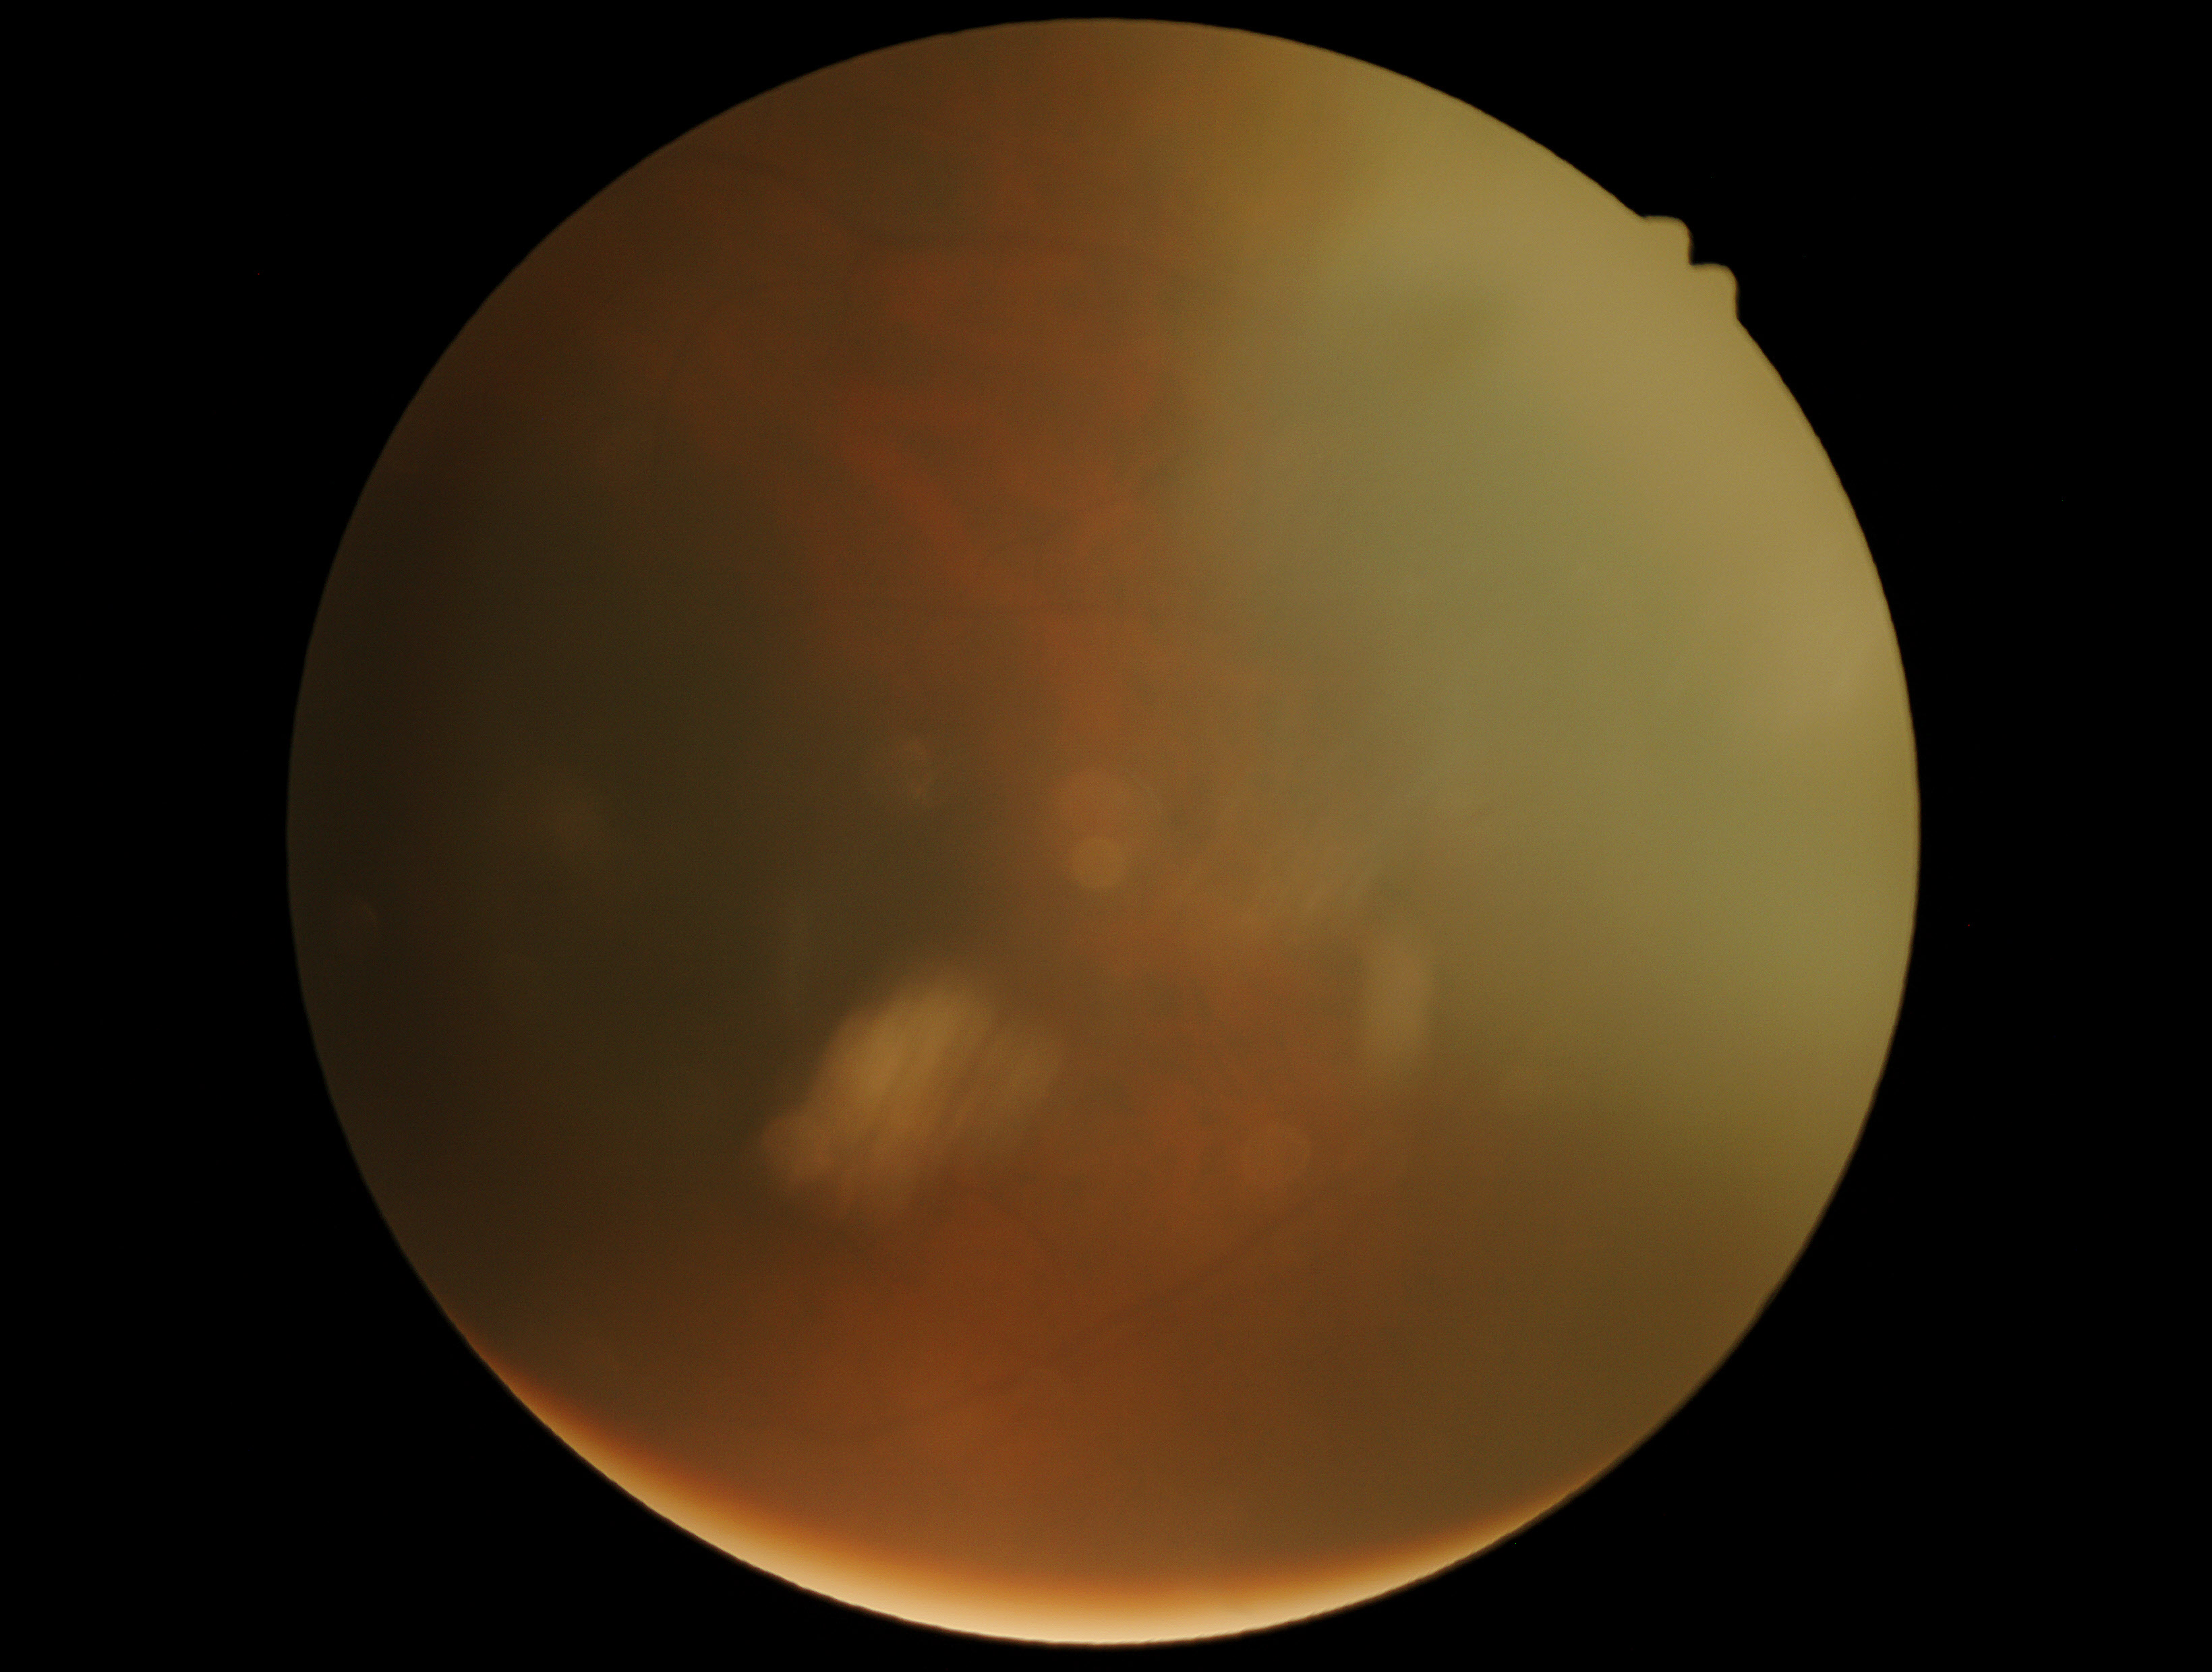 Image quality is insufficient for diabetic retinopathy assessment. DR stage: ungradable.